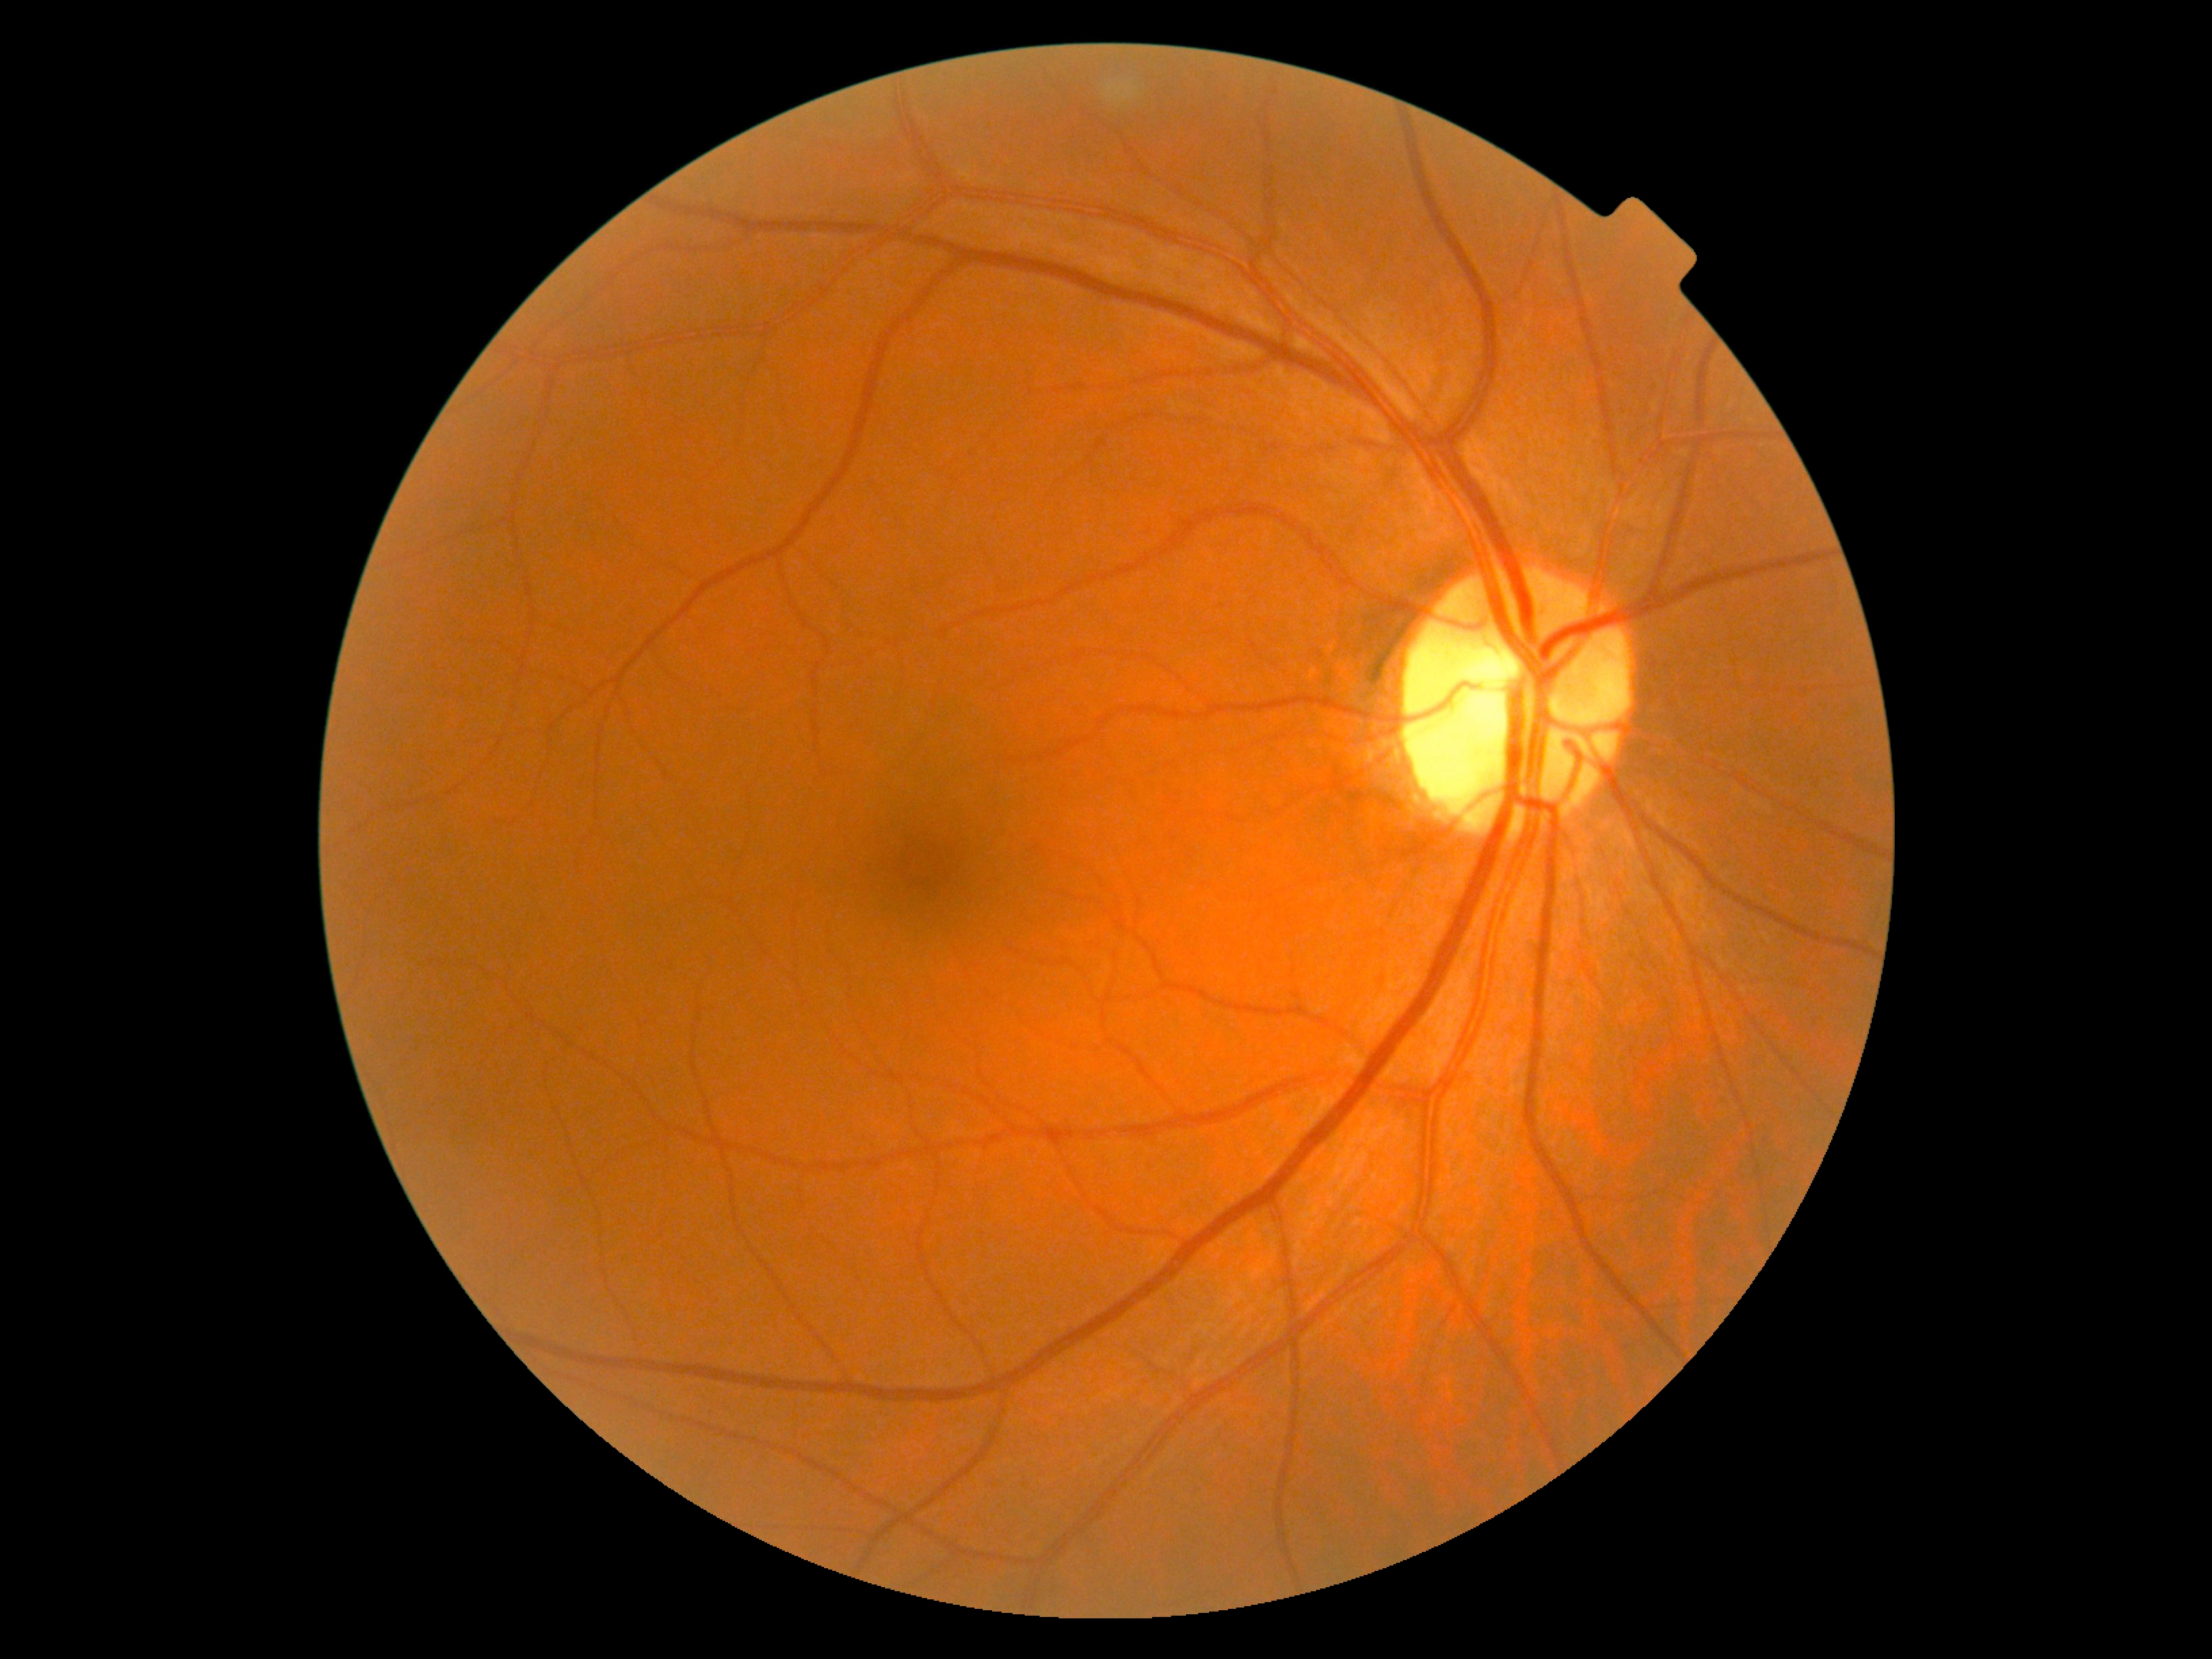 Diabetic retinopathy (DR): 0.